Infant wide-field fundus photograph; 130° field of view (Natus RetCam Envision)
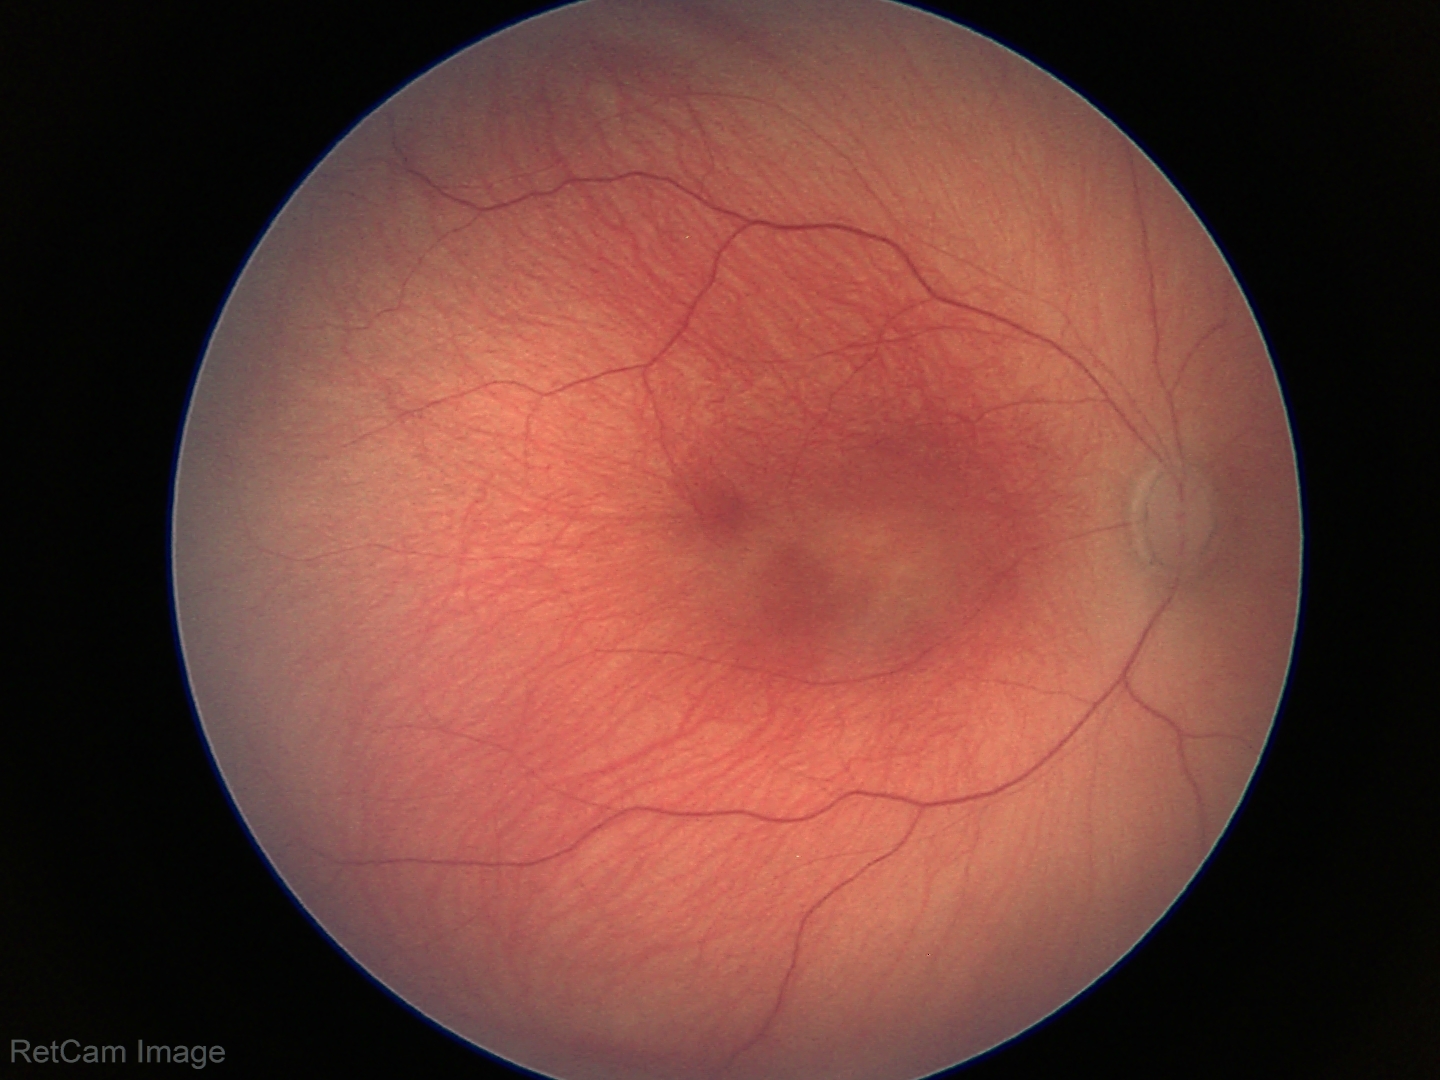
Plus disease absent.
Examination diagnosed as status post ROP.